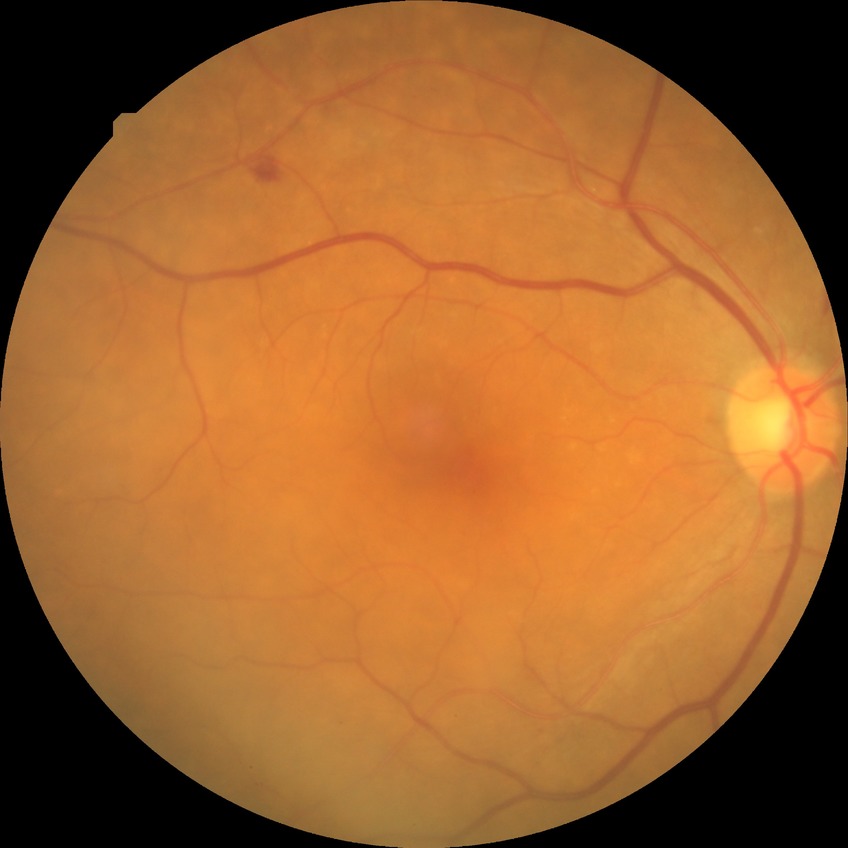 Diabetic retinopathy (DR): SDR (simple diabetic retinopathy).